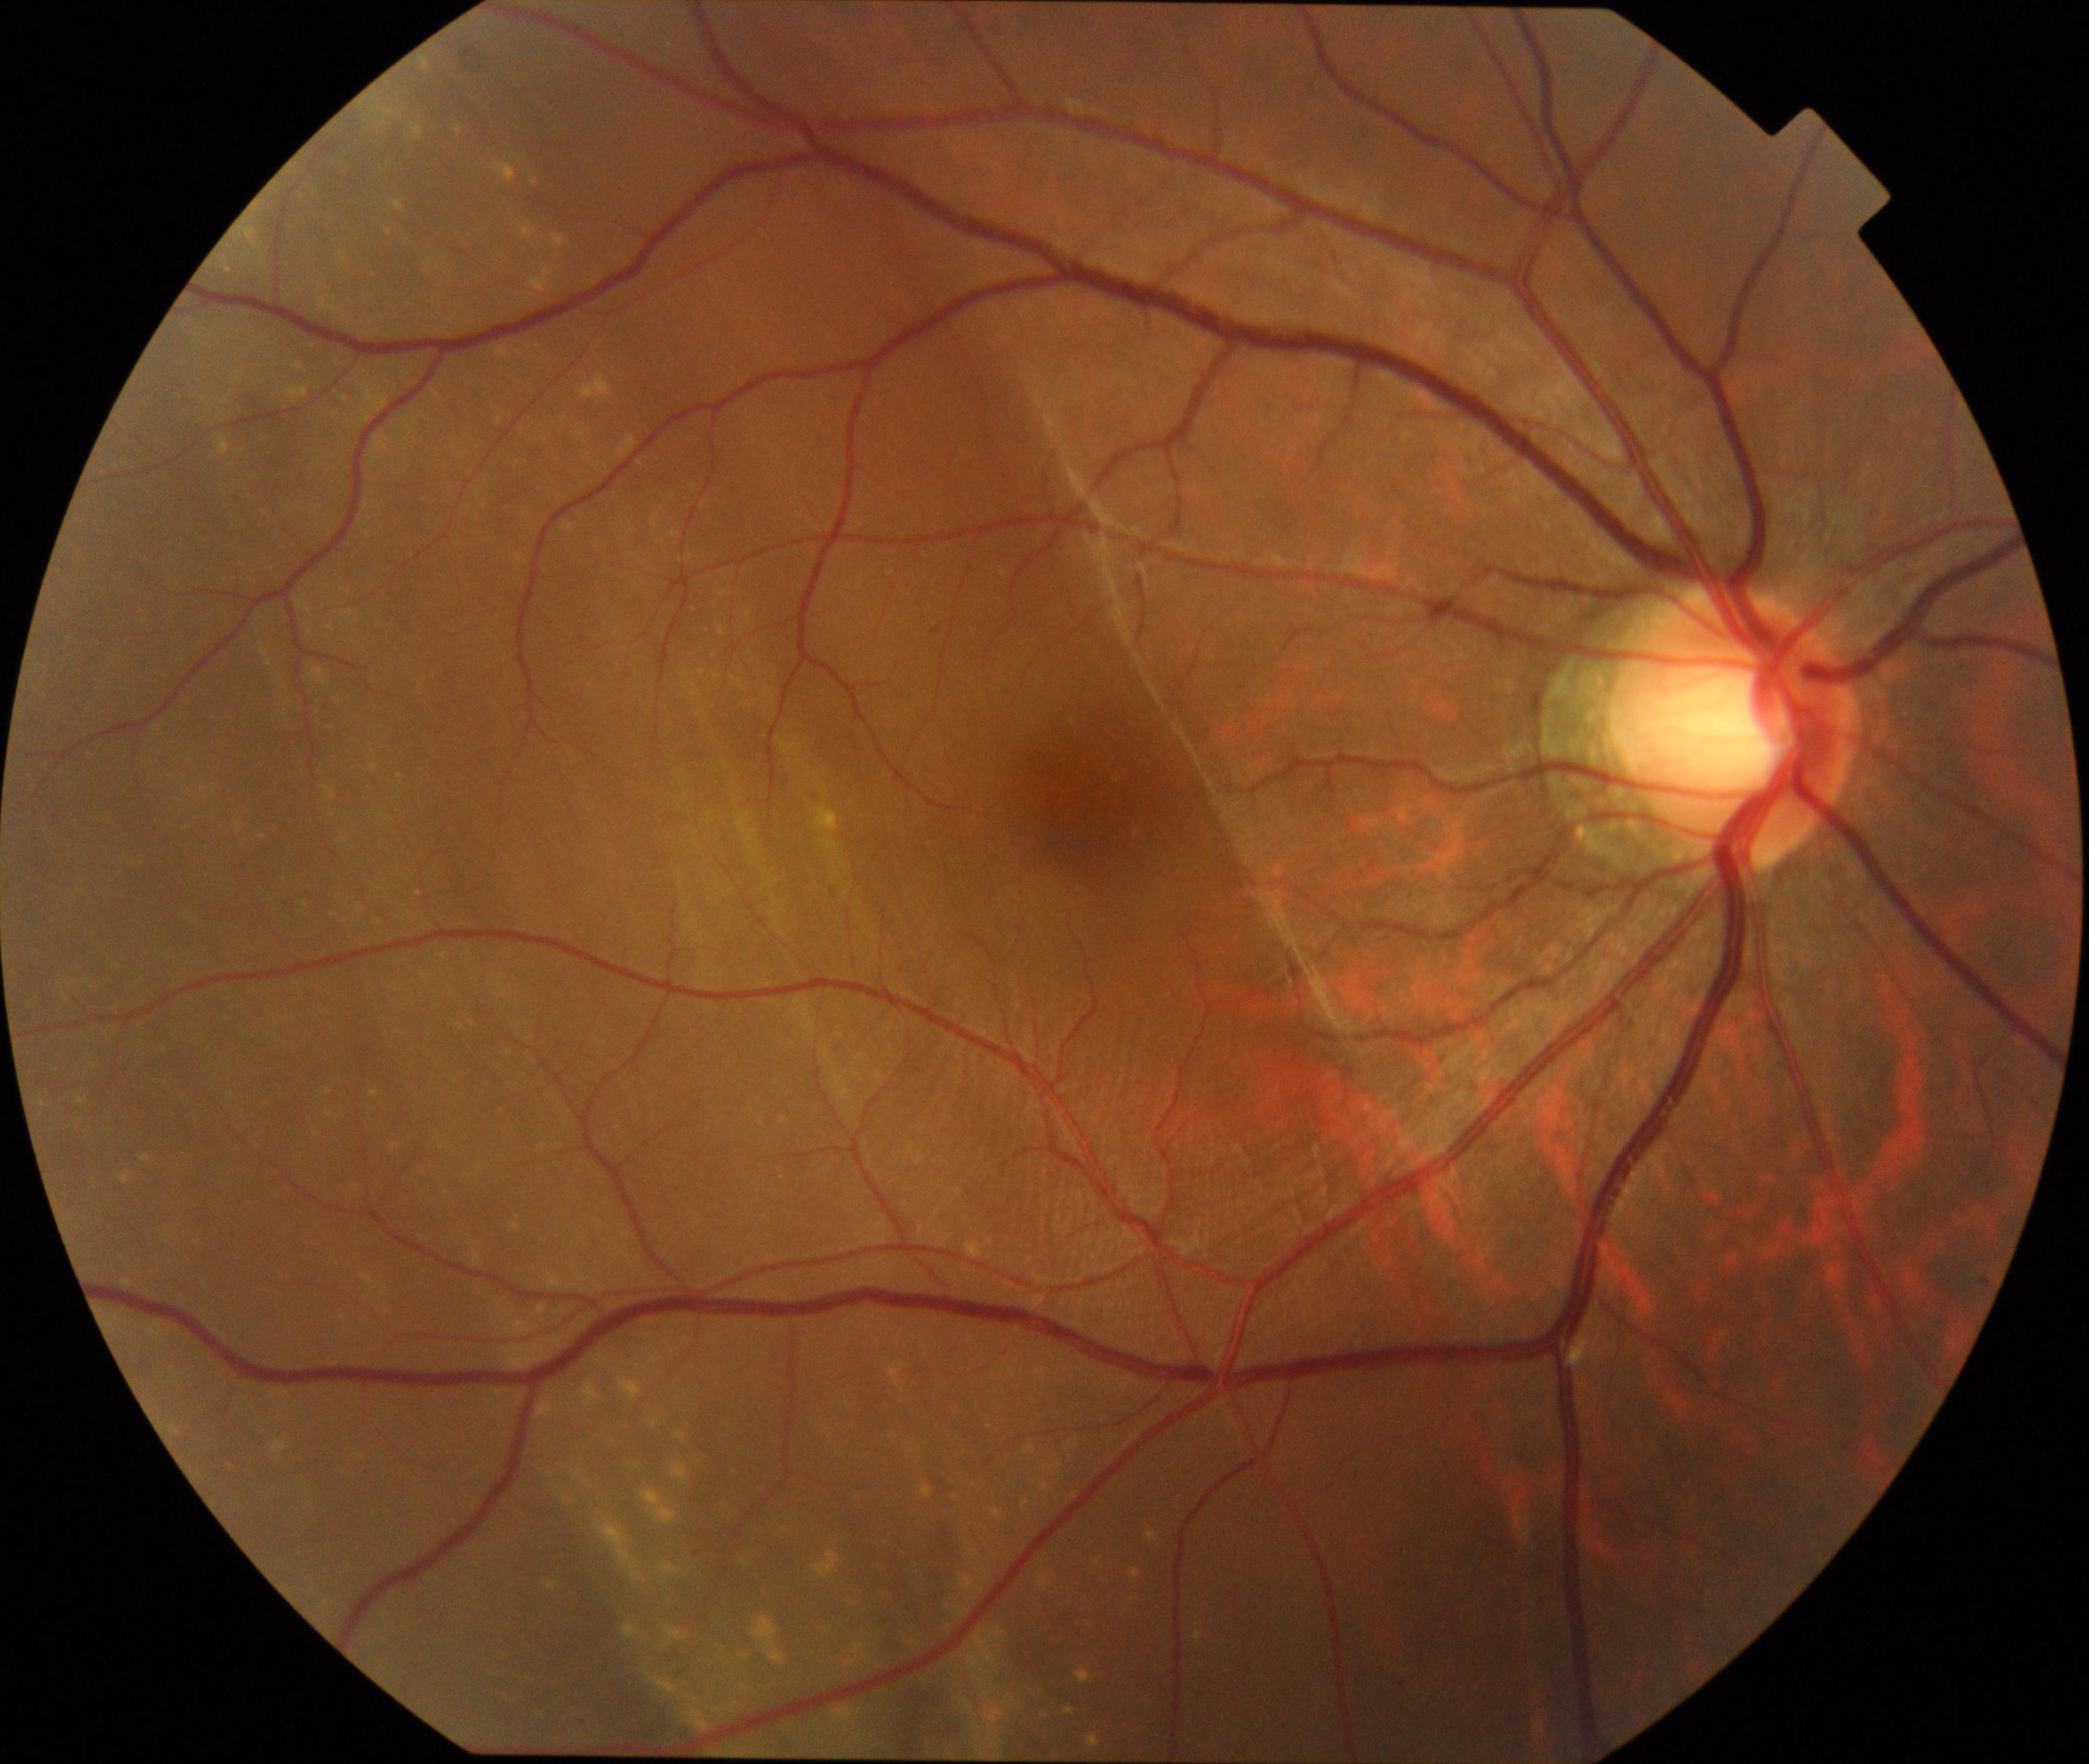
The image shows rhegmatogenous retinal detachment.